45° field of view; NIDEK AFC-230 fundus camera
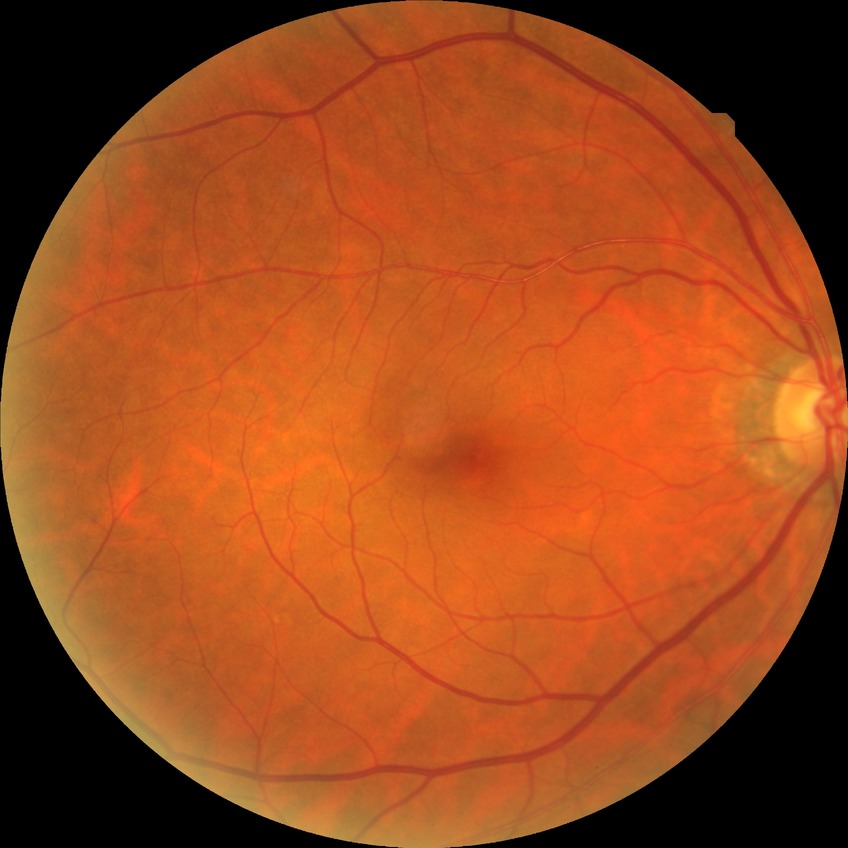
DR stage: NDR.